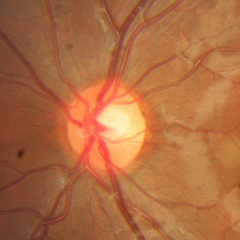 No glaucomatous findings.